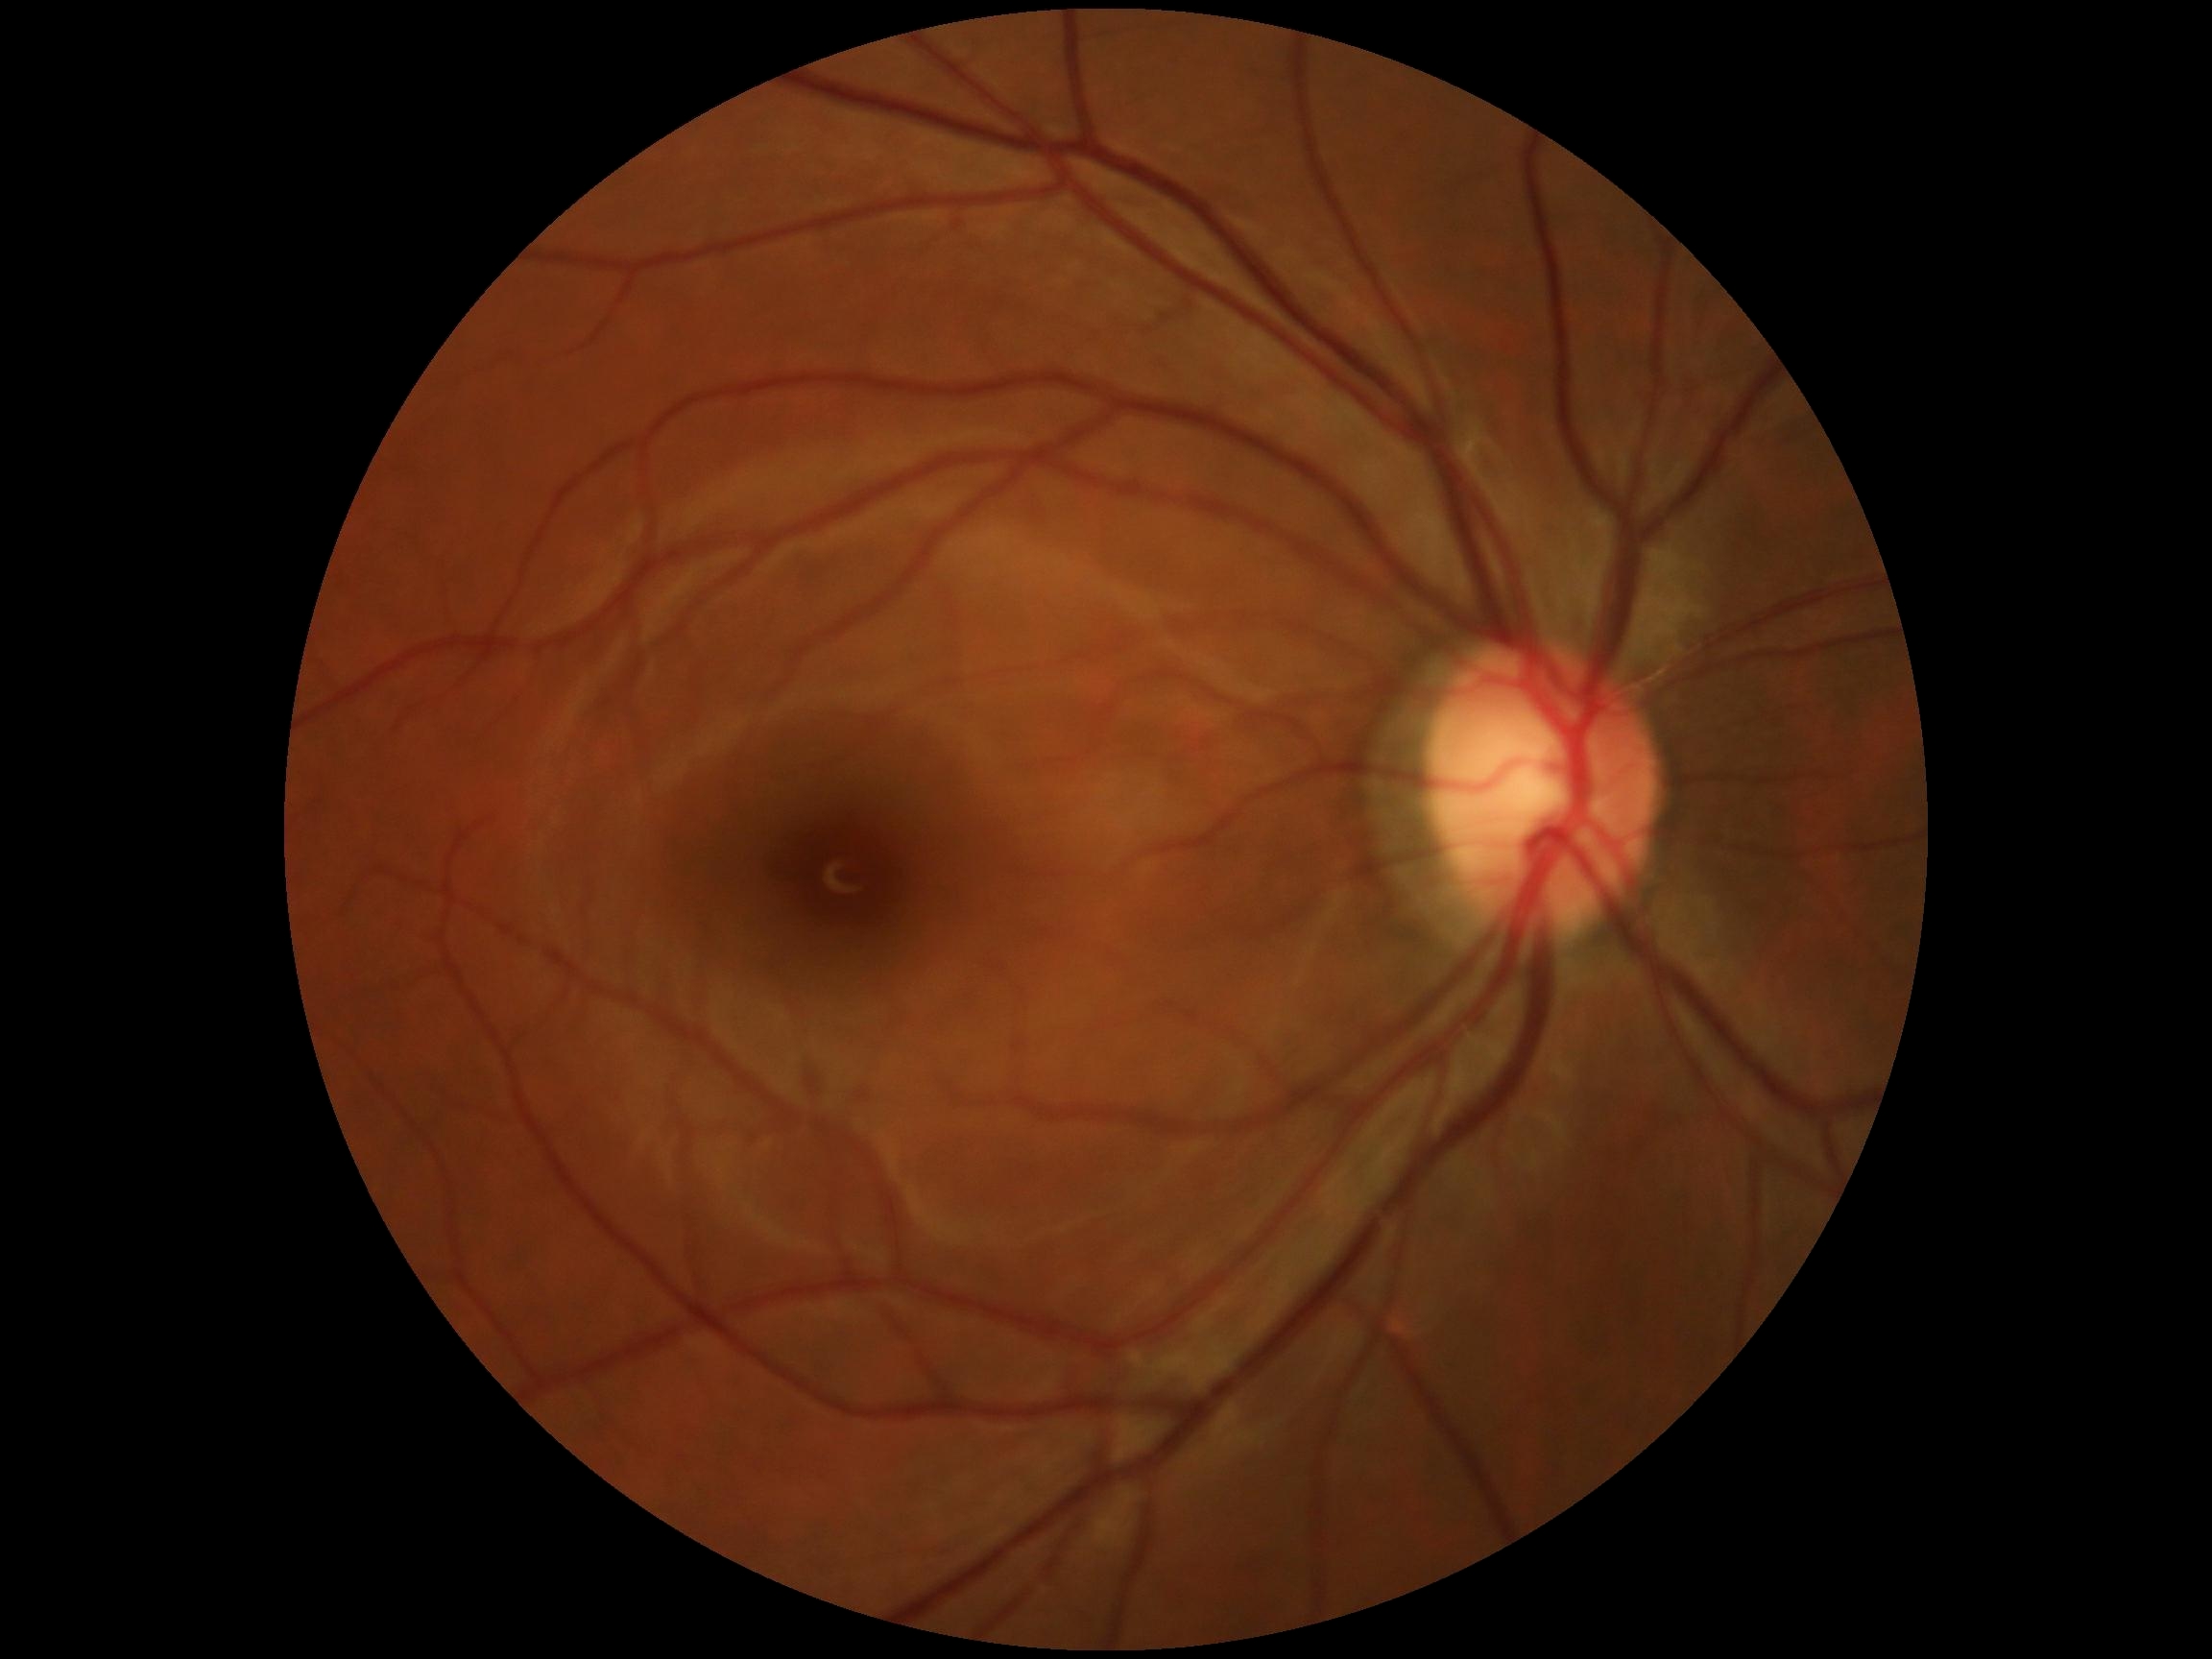 DR grade@0 (no apparent retinopathy).